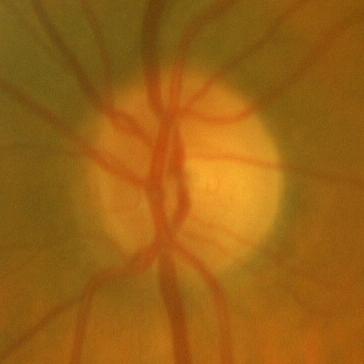

This optic disc photograph shows no glaucomatous findings.